FOV: 45 degrees — 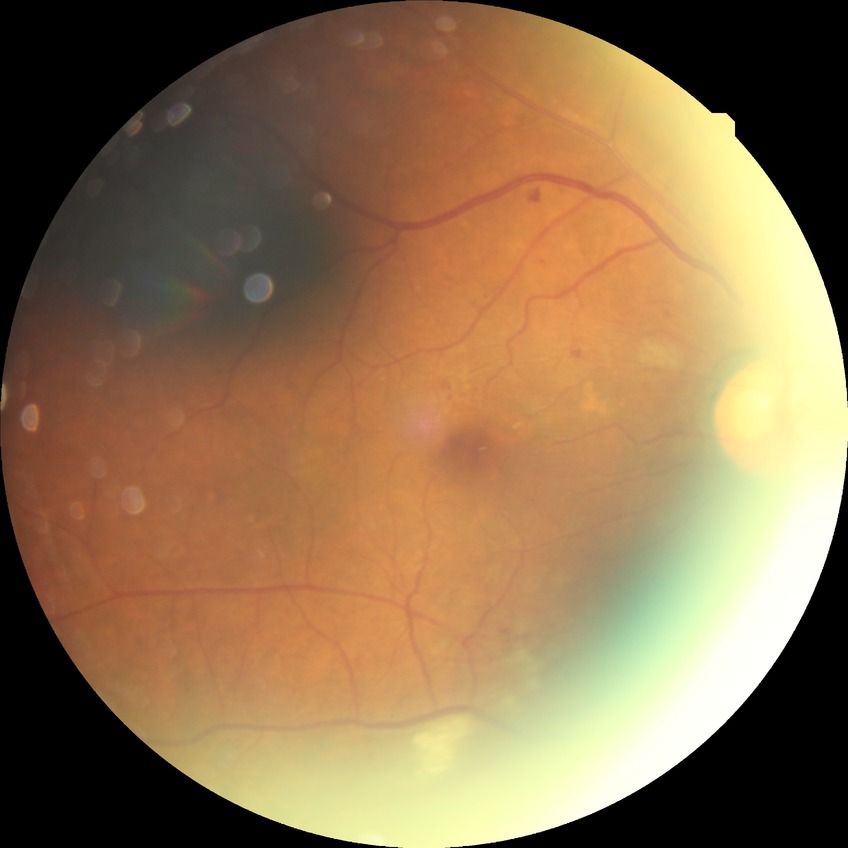

Davis grade: PPDR.